640 by 480 pixels · wide-field contact fundus photograph of an infant:
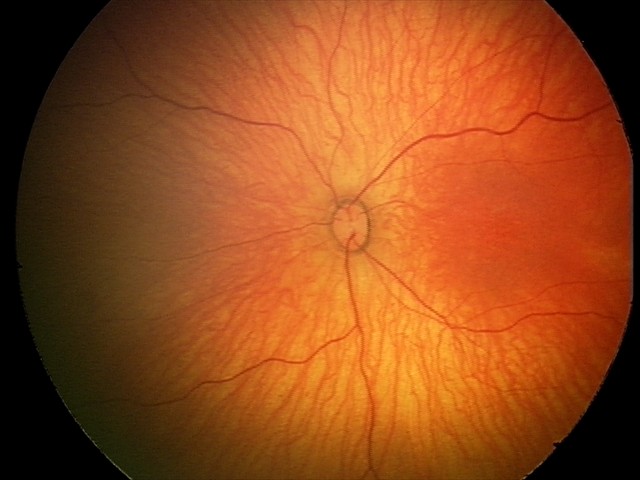
Screening diagnosis: no abnormal retinal findings.